CFP
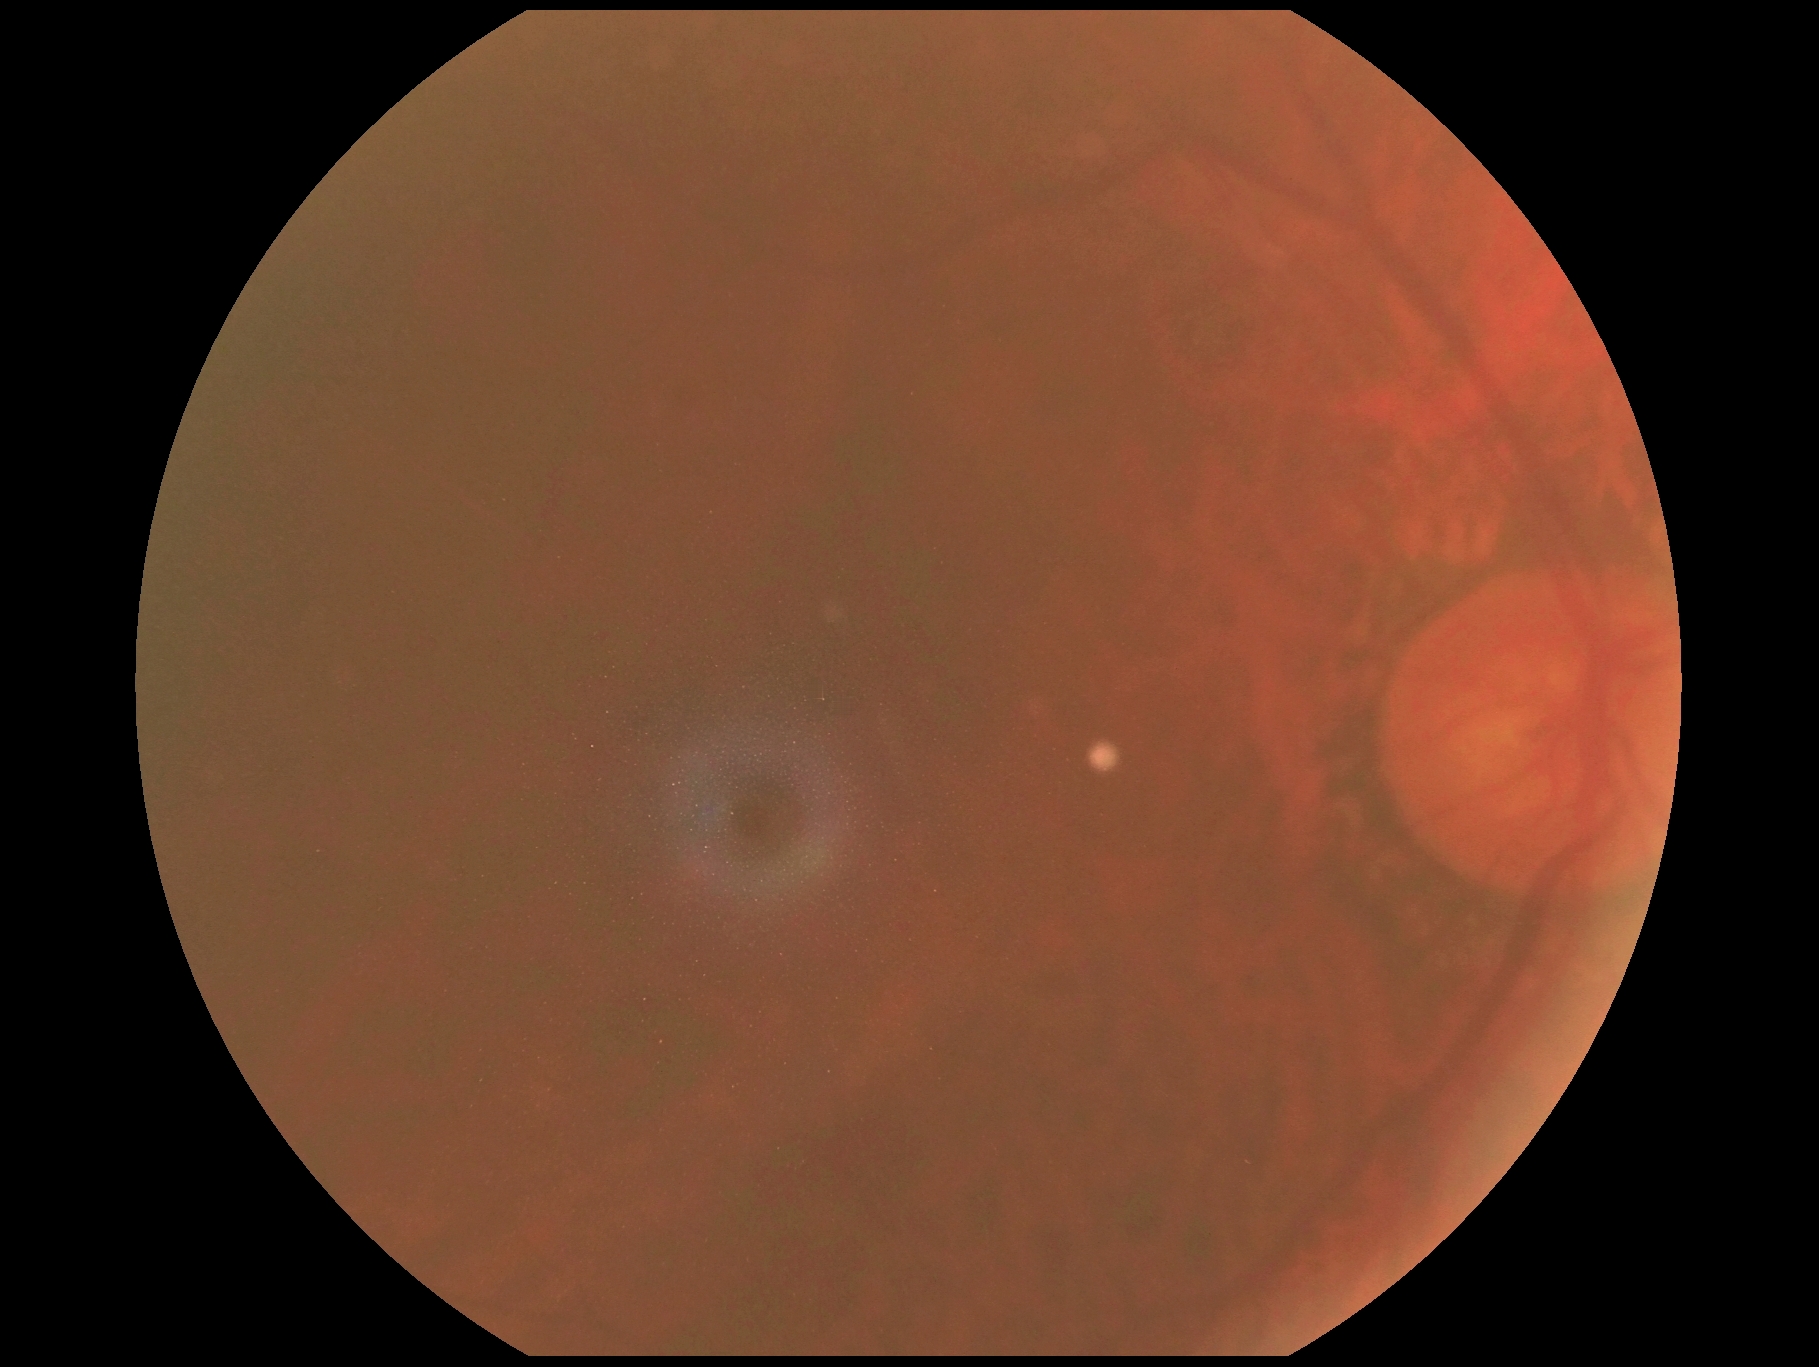
DR severity: ungradable due to poor image quality. Quality too poor to assess for DR.